RetCam wide-field infant fundus image. Camera: Clarity RetCam 3 (130° FOV). 640 x 480 pixels
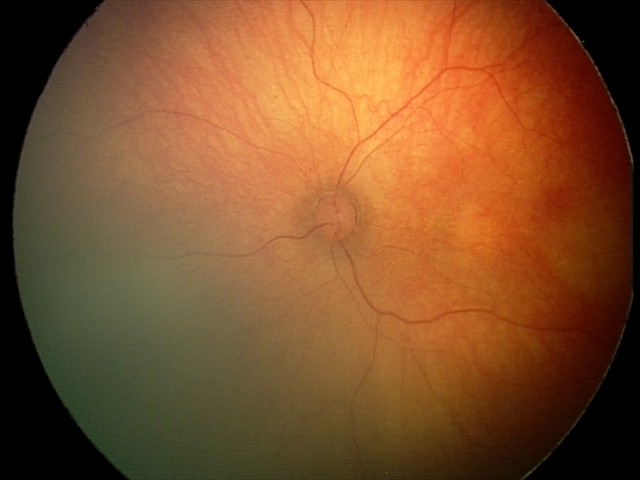

Physiological retinal appearance for postconceptual age.